1932 by 1932 pixels, 50-degree field of view, Topcon TRC-NW8
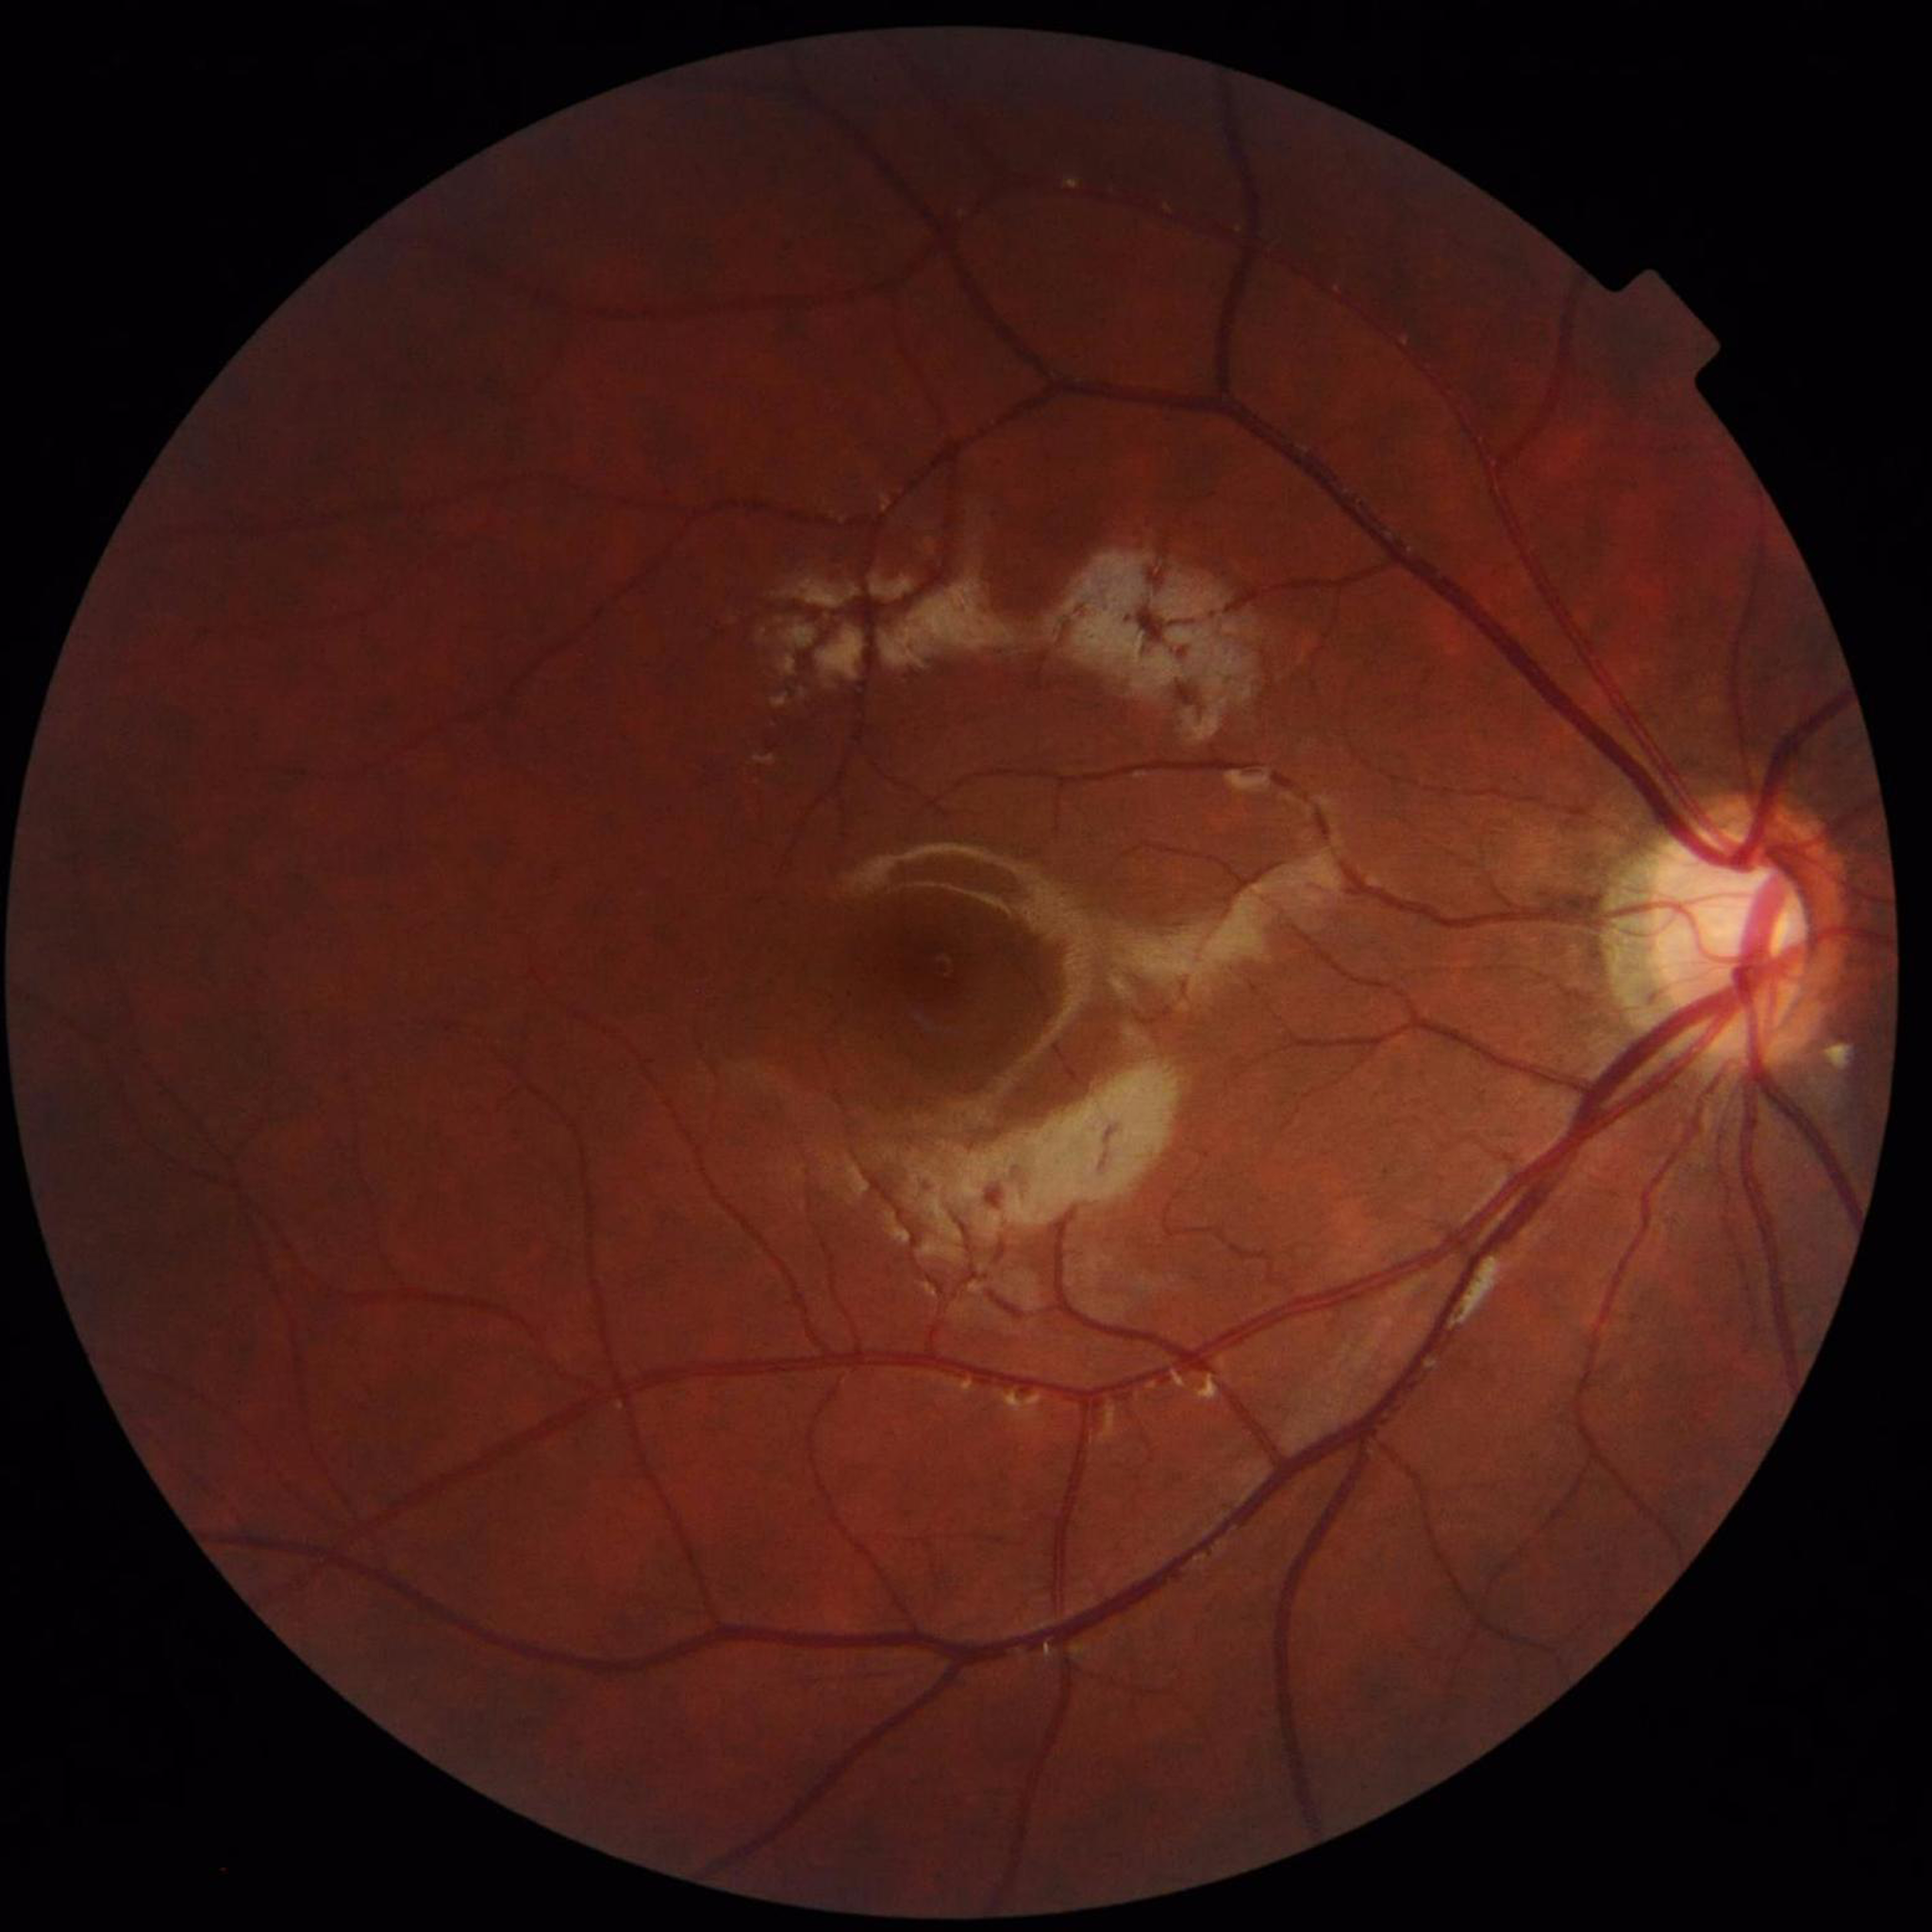

diagnosis: no AMD, DR, or glaucoma